Pediatric wide-field fundus photograph; acquired on the Phoenix ICON; 1240 x 1240 pixels.
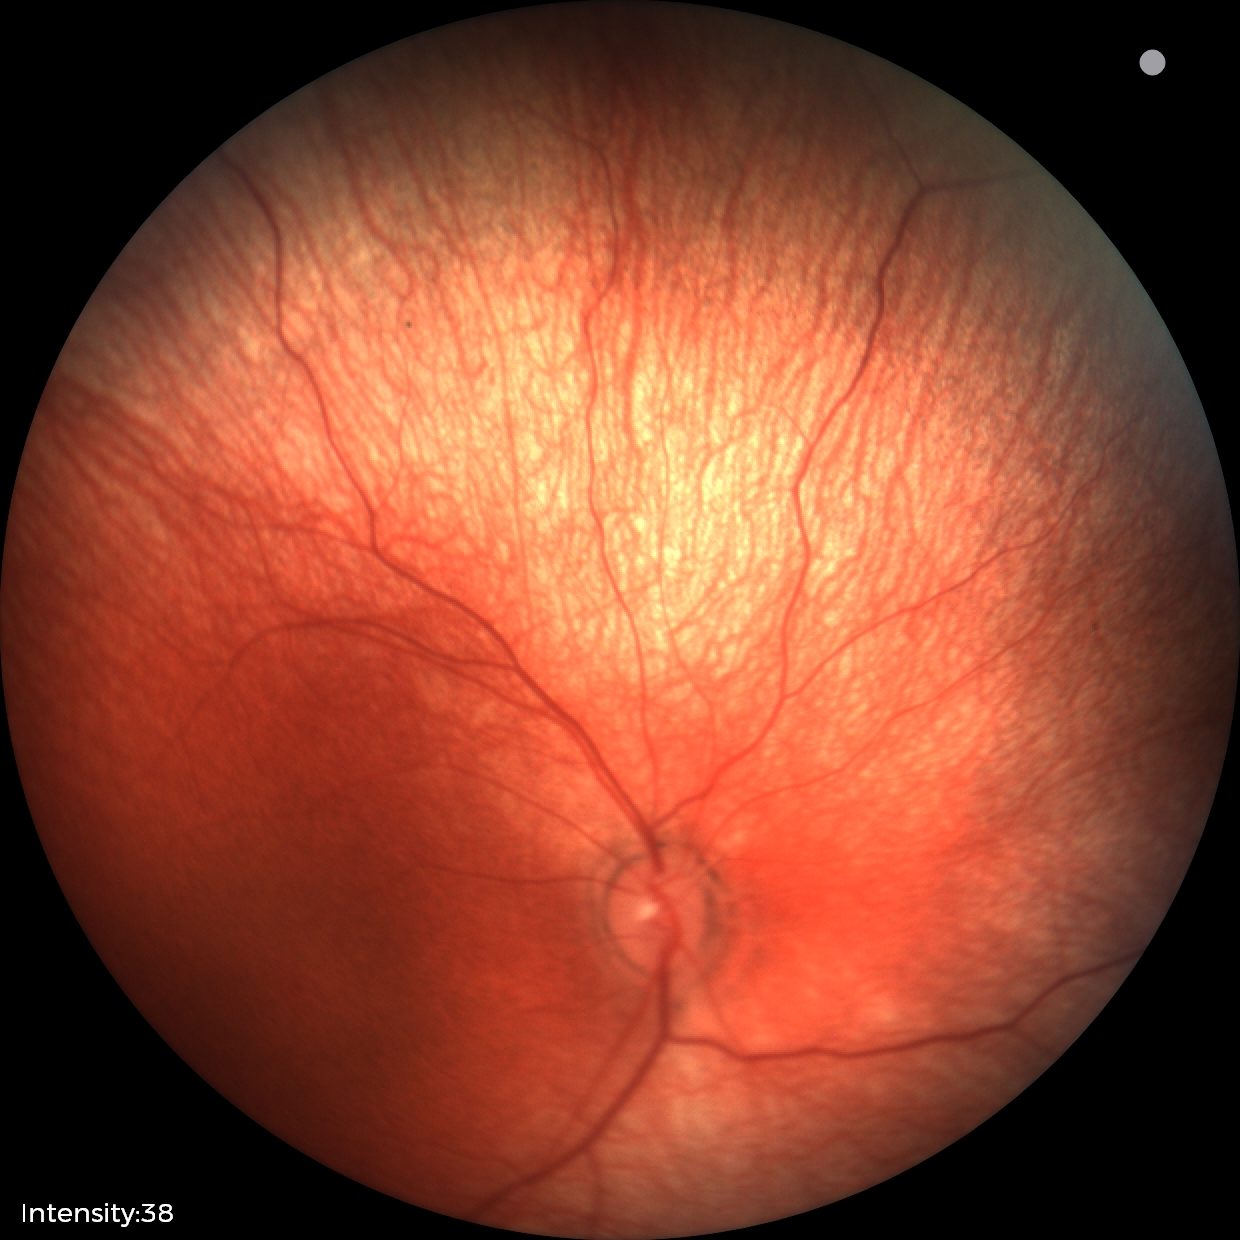 Normal screening examination.